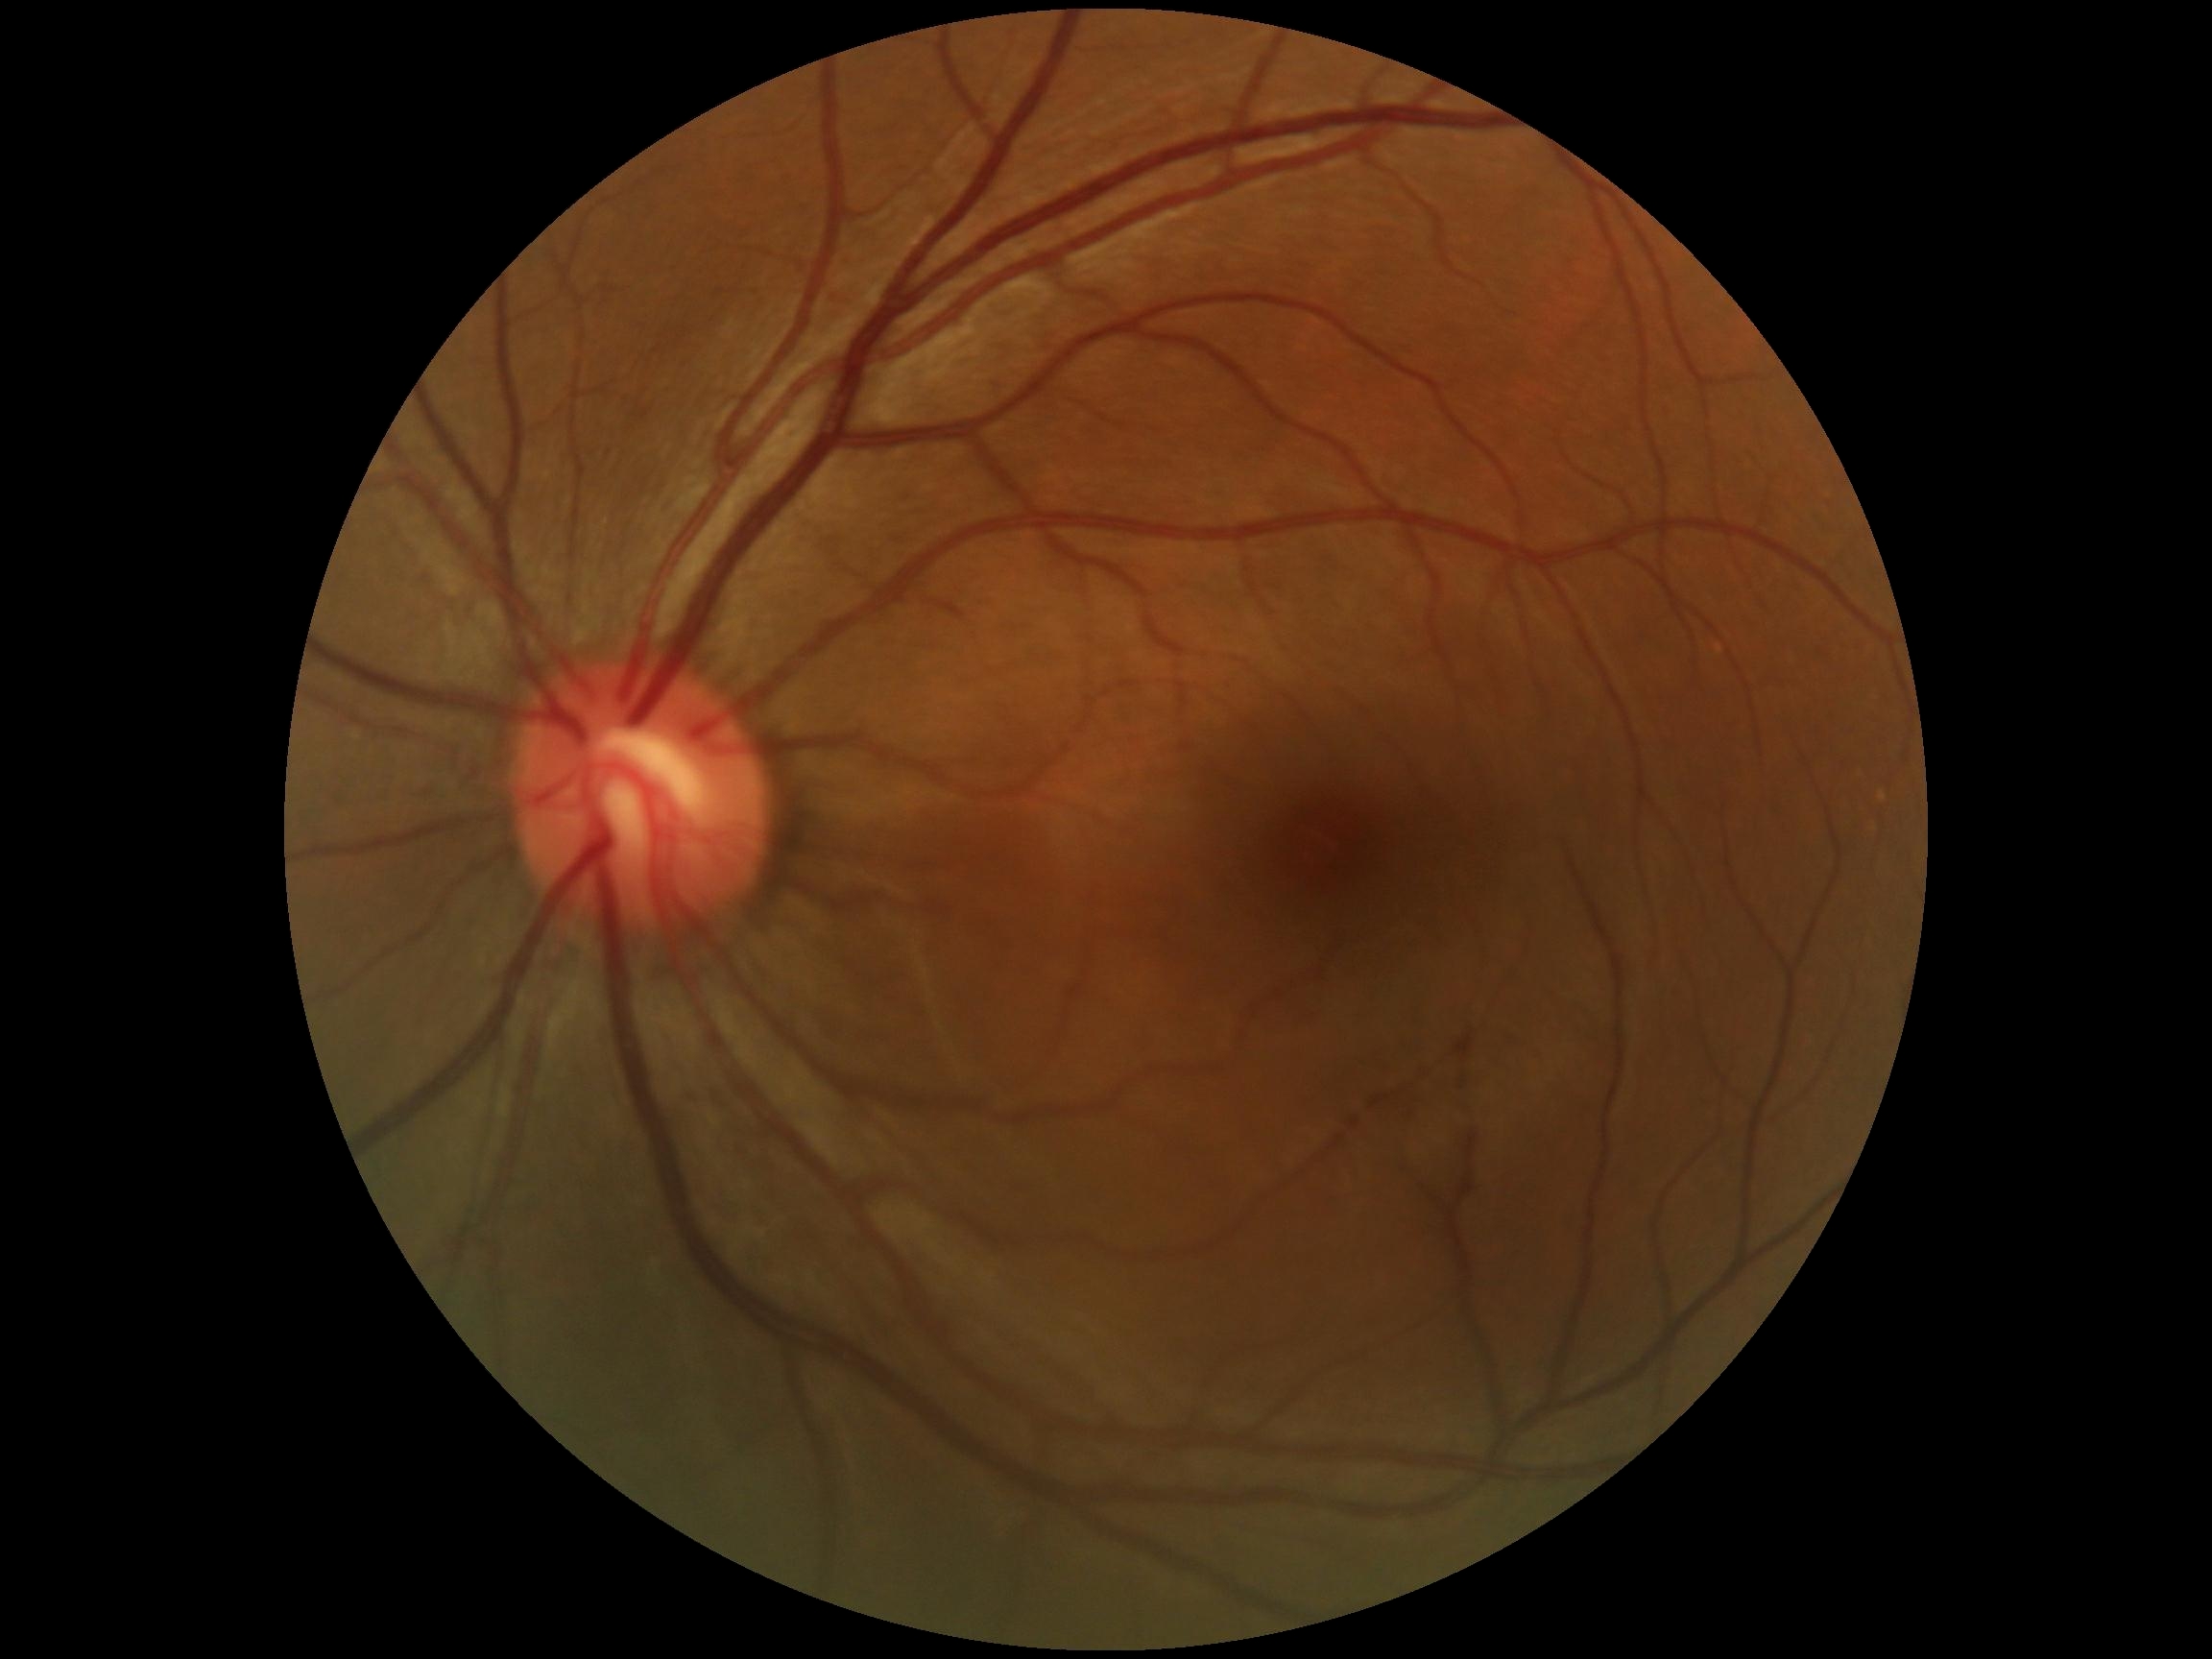 DR stage: grade 0 — no visible signs of diabetic retinopathy.